1705x1705 · color fundus photograph from a handheld portable camera — 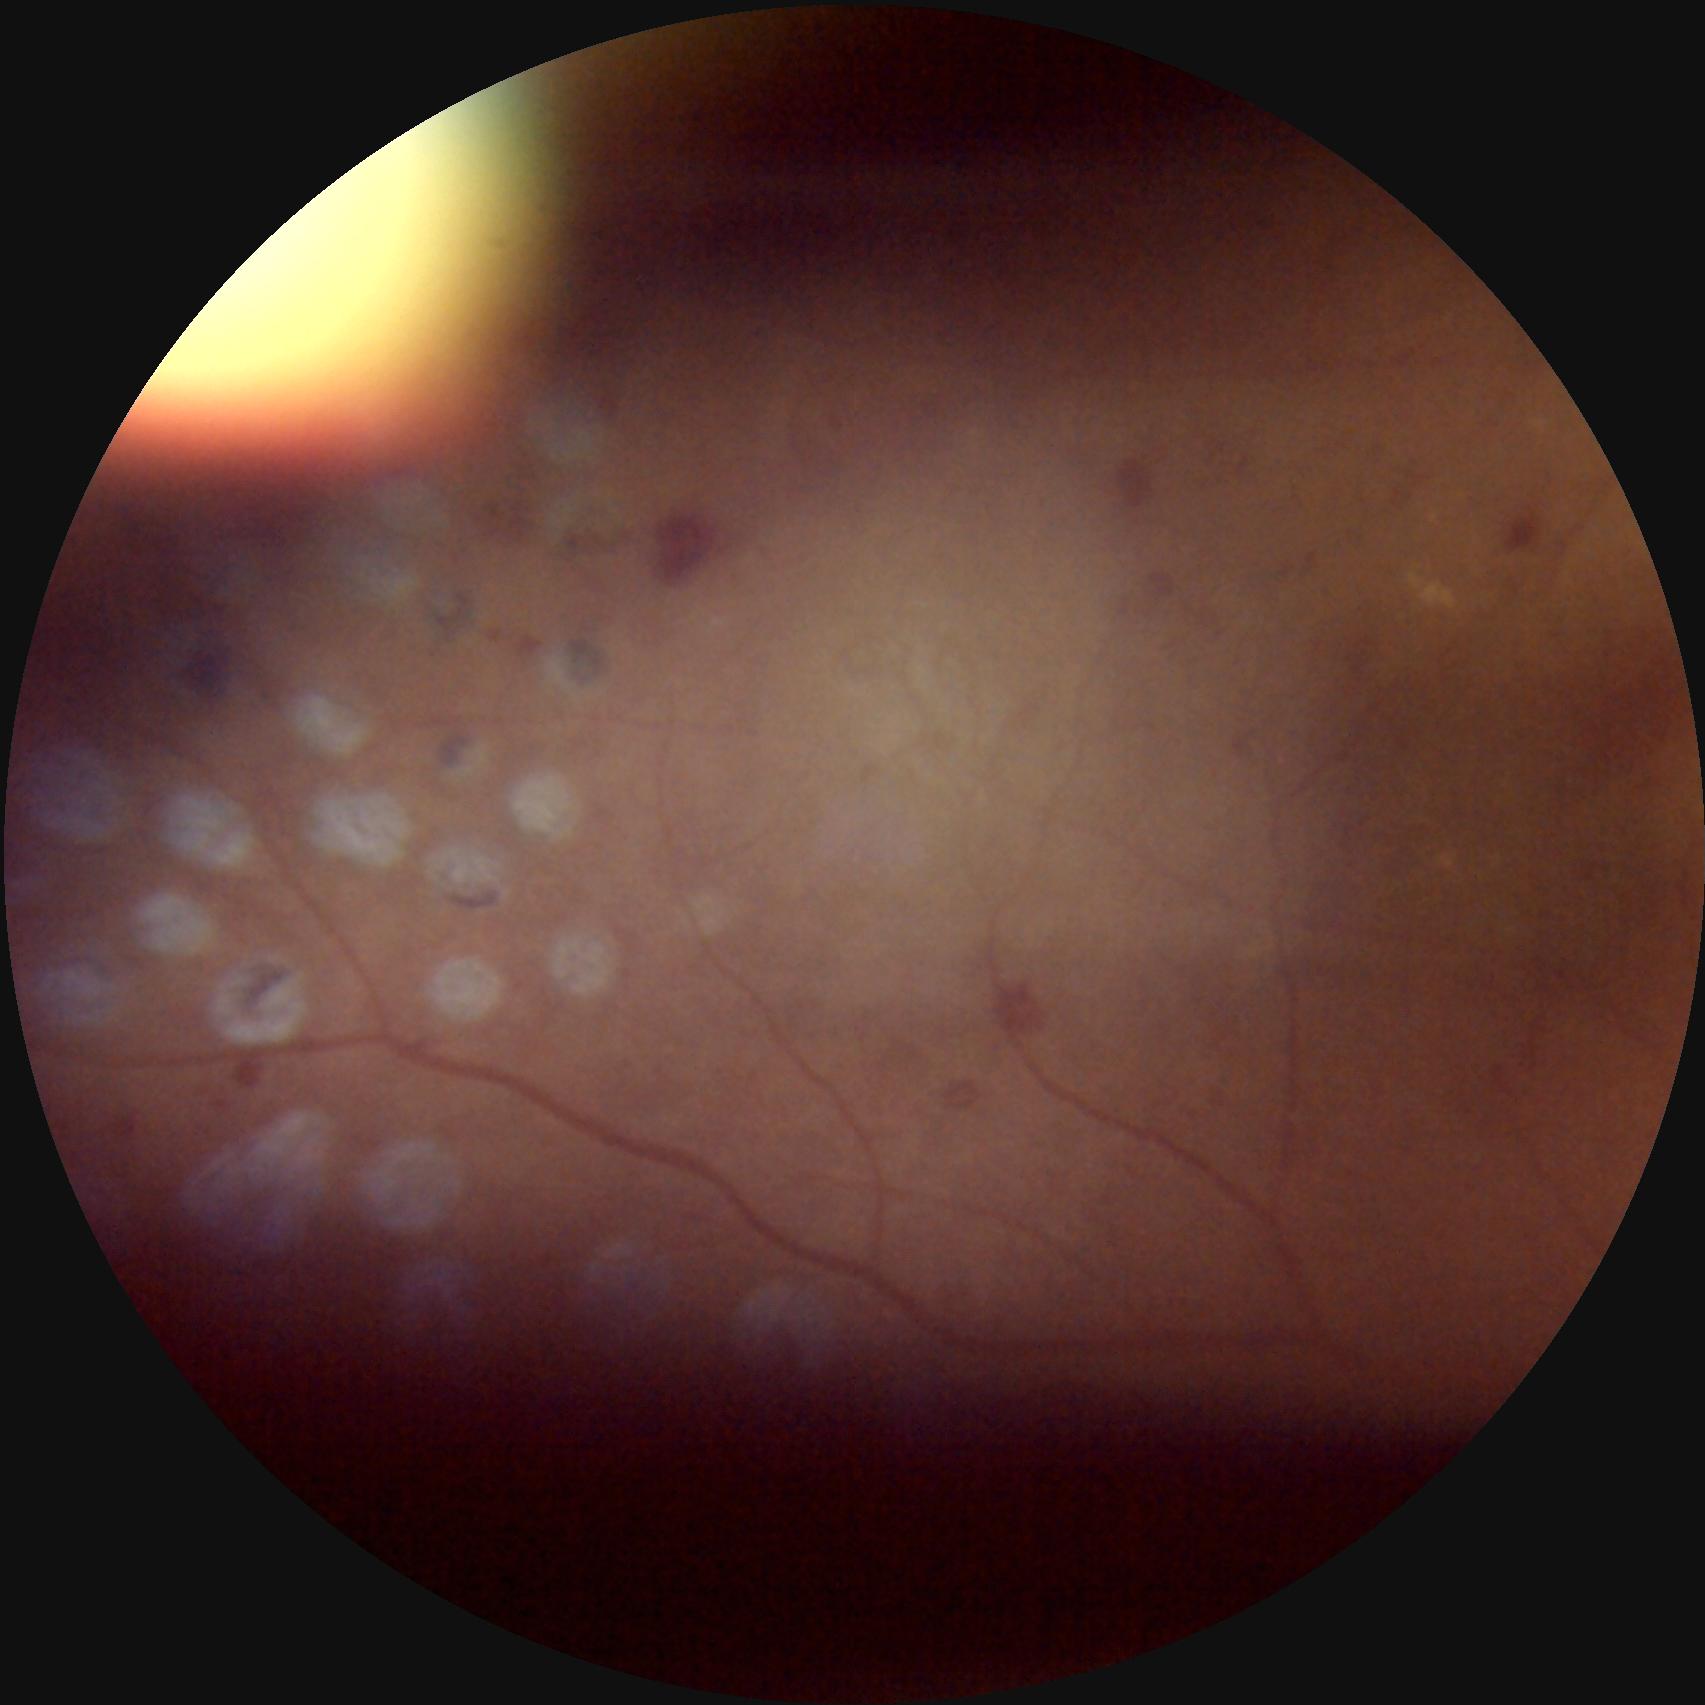

Clarity = out of focus; Illumination = suboptimal; Contrast = poor; Overall image quality = low.